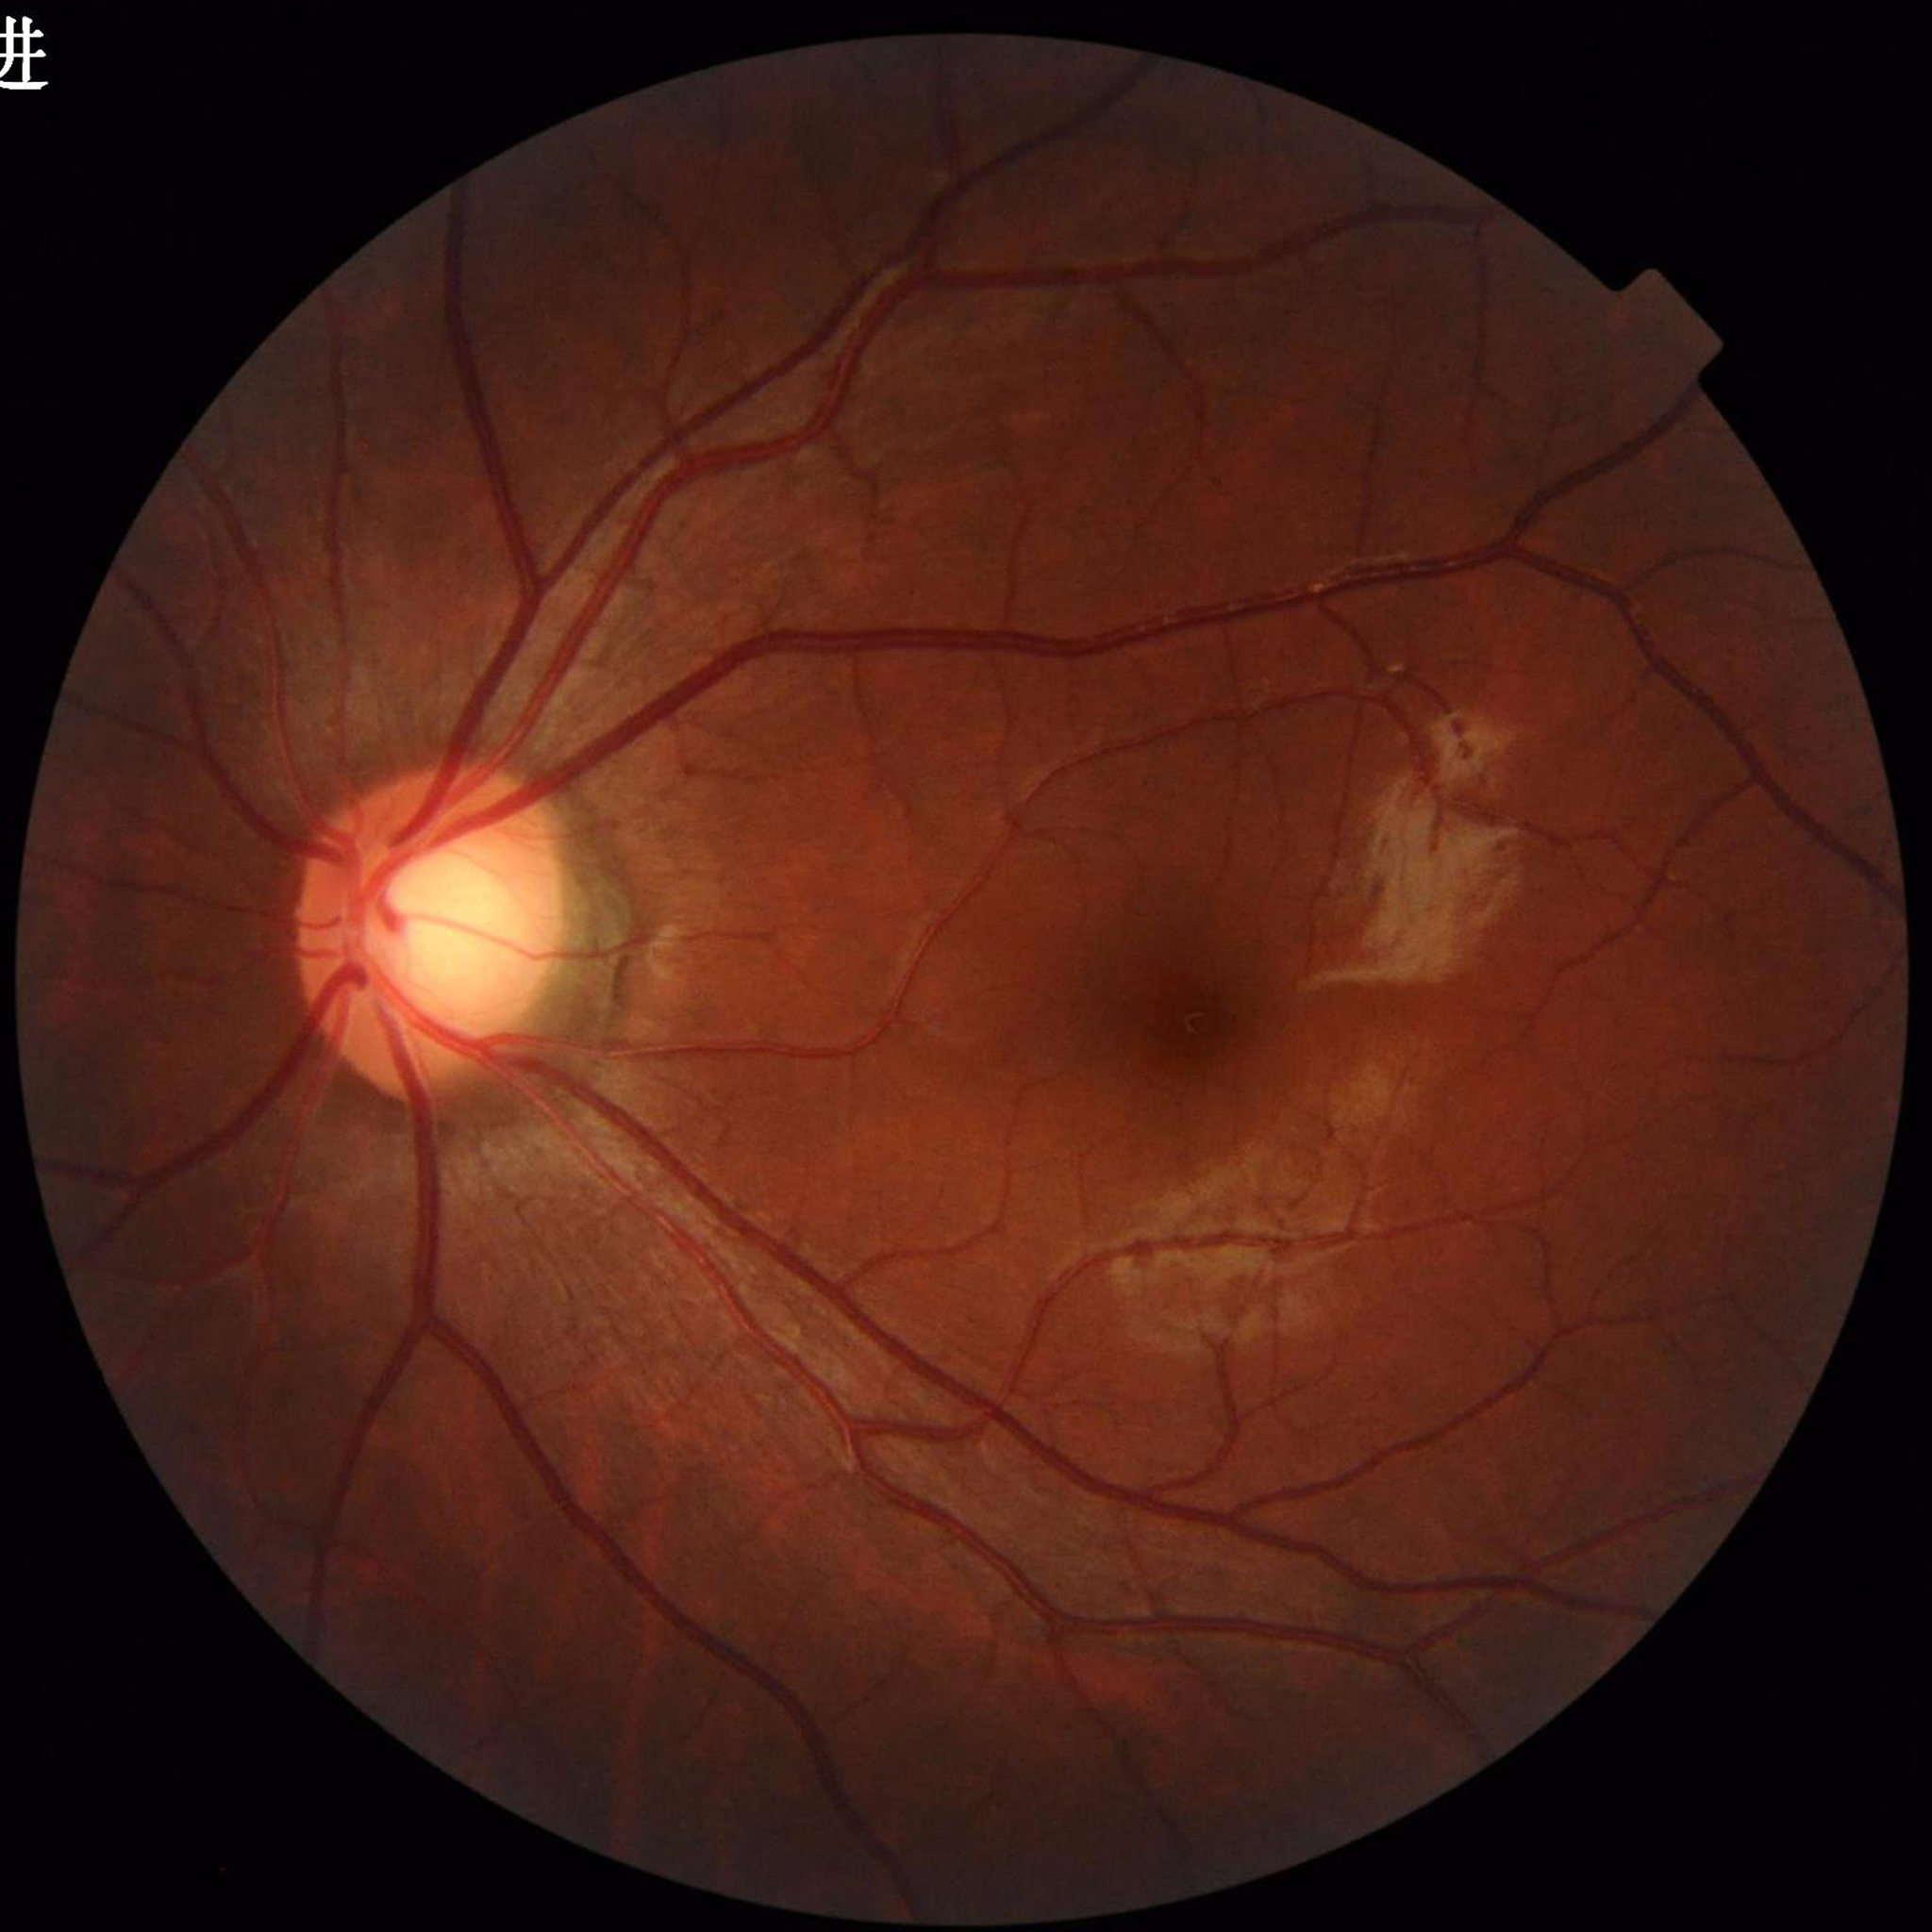 Diagnosed with glaucoma. Photo quality: no quality issues identified.